Diabetic retinopathy graded by the modified Davis classification.
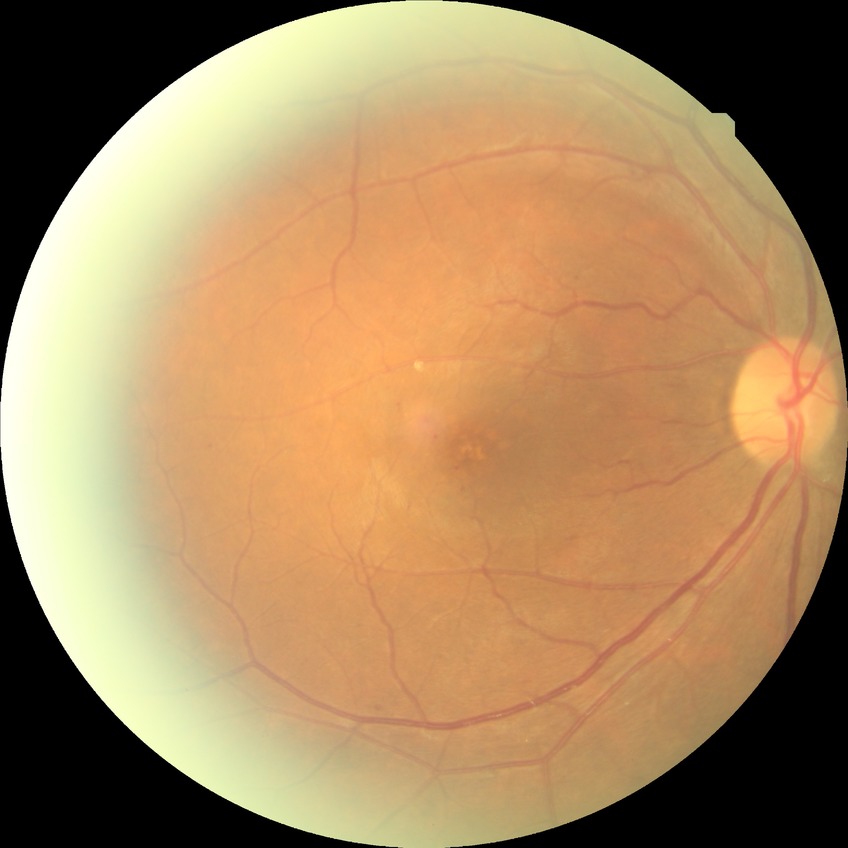 Diabetic retinopathy (DR): simple diabetic retinopathy (SDR).